Posterior pole color fundus photograph: 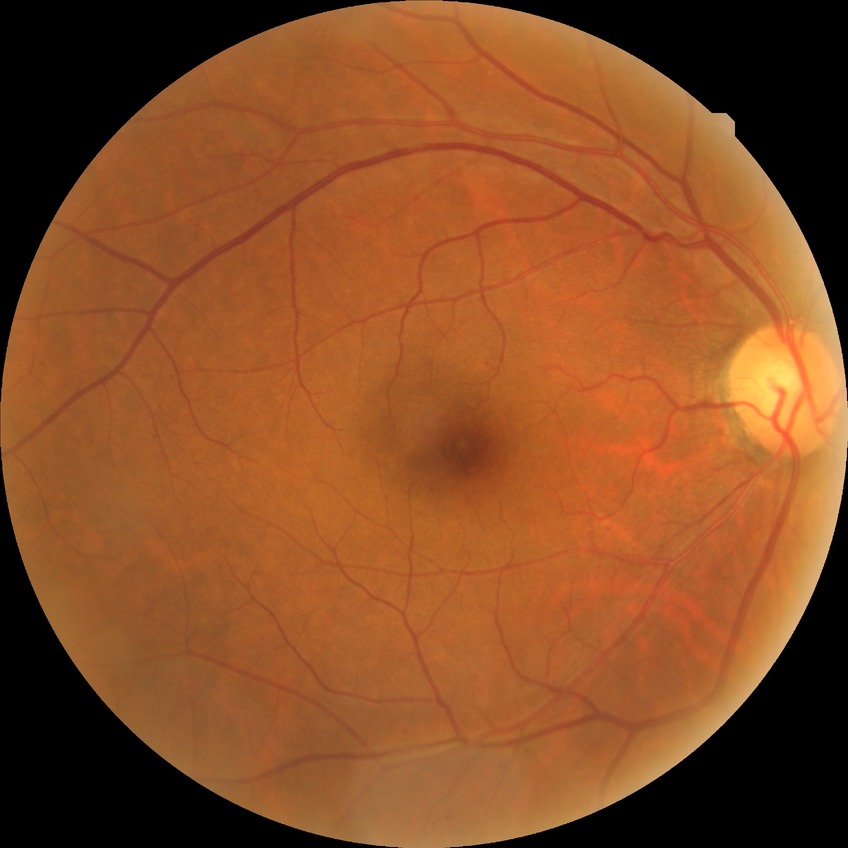 diabetic retinopathy (DR) = simple diabetic retinopathy (SDR)